Captured without pupil dilation
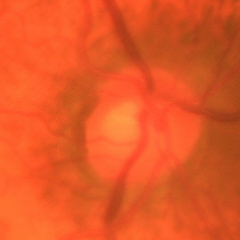 Glaucomatous changes are present. Fundus appearance consistent with early glaucoma.